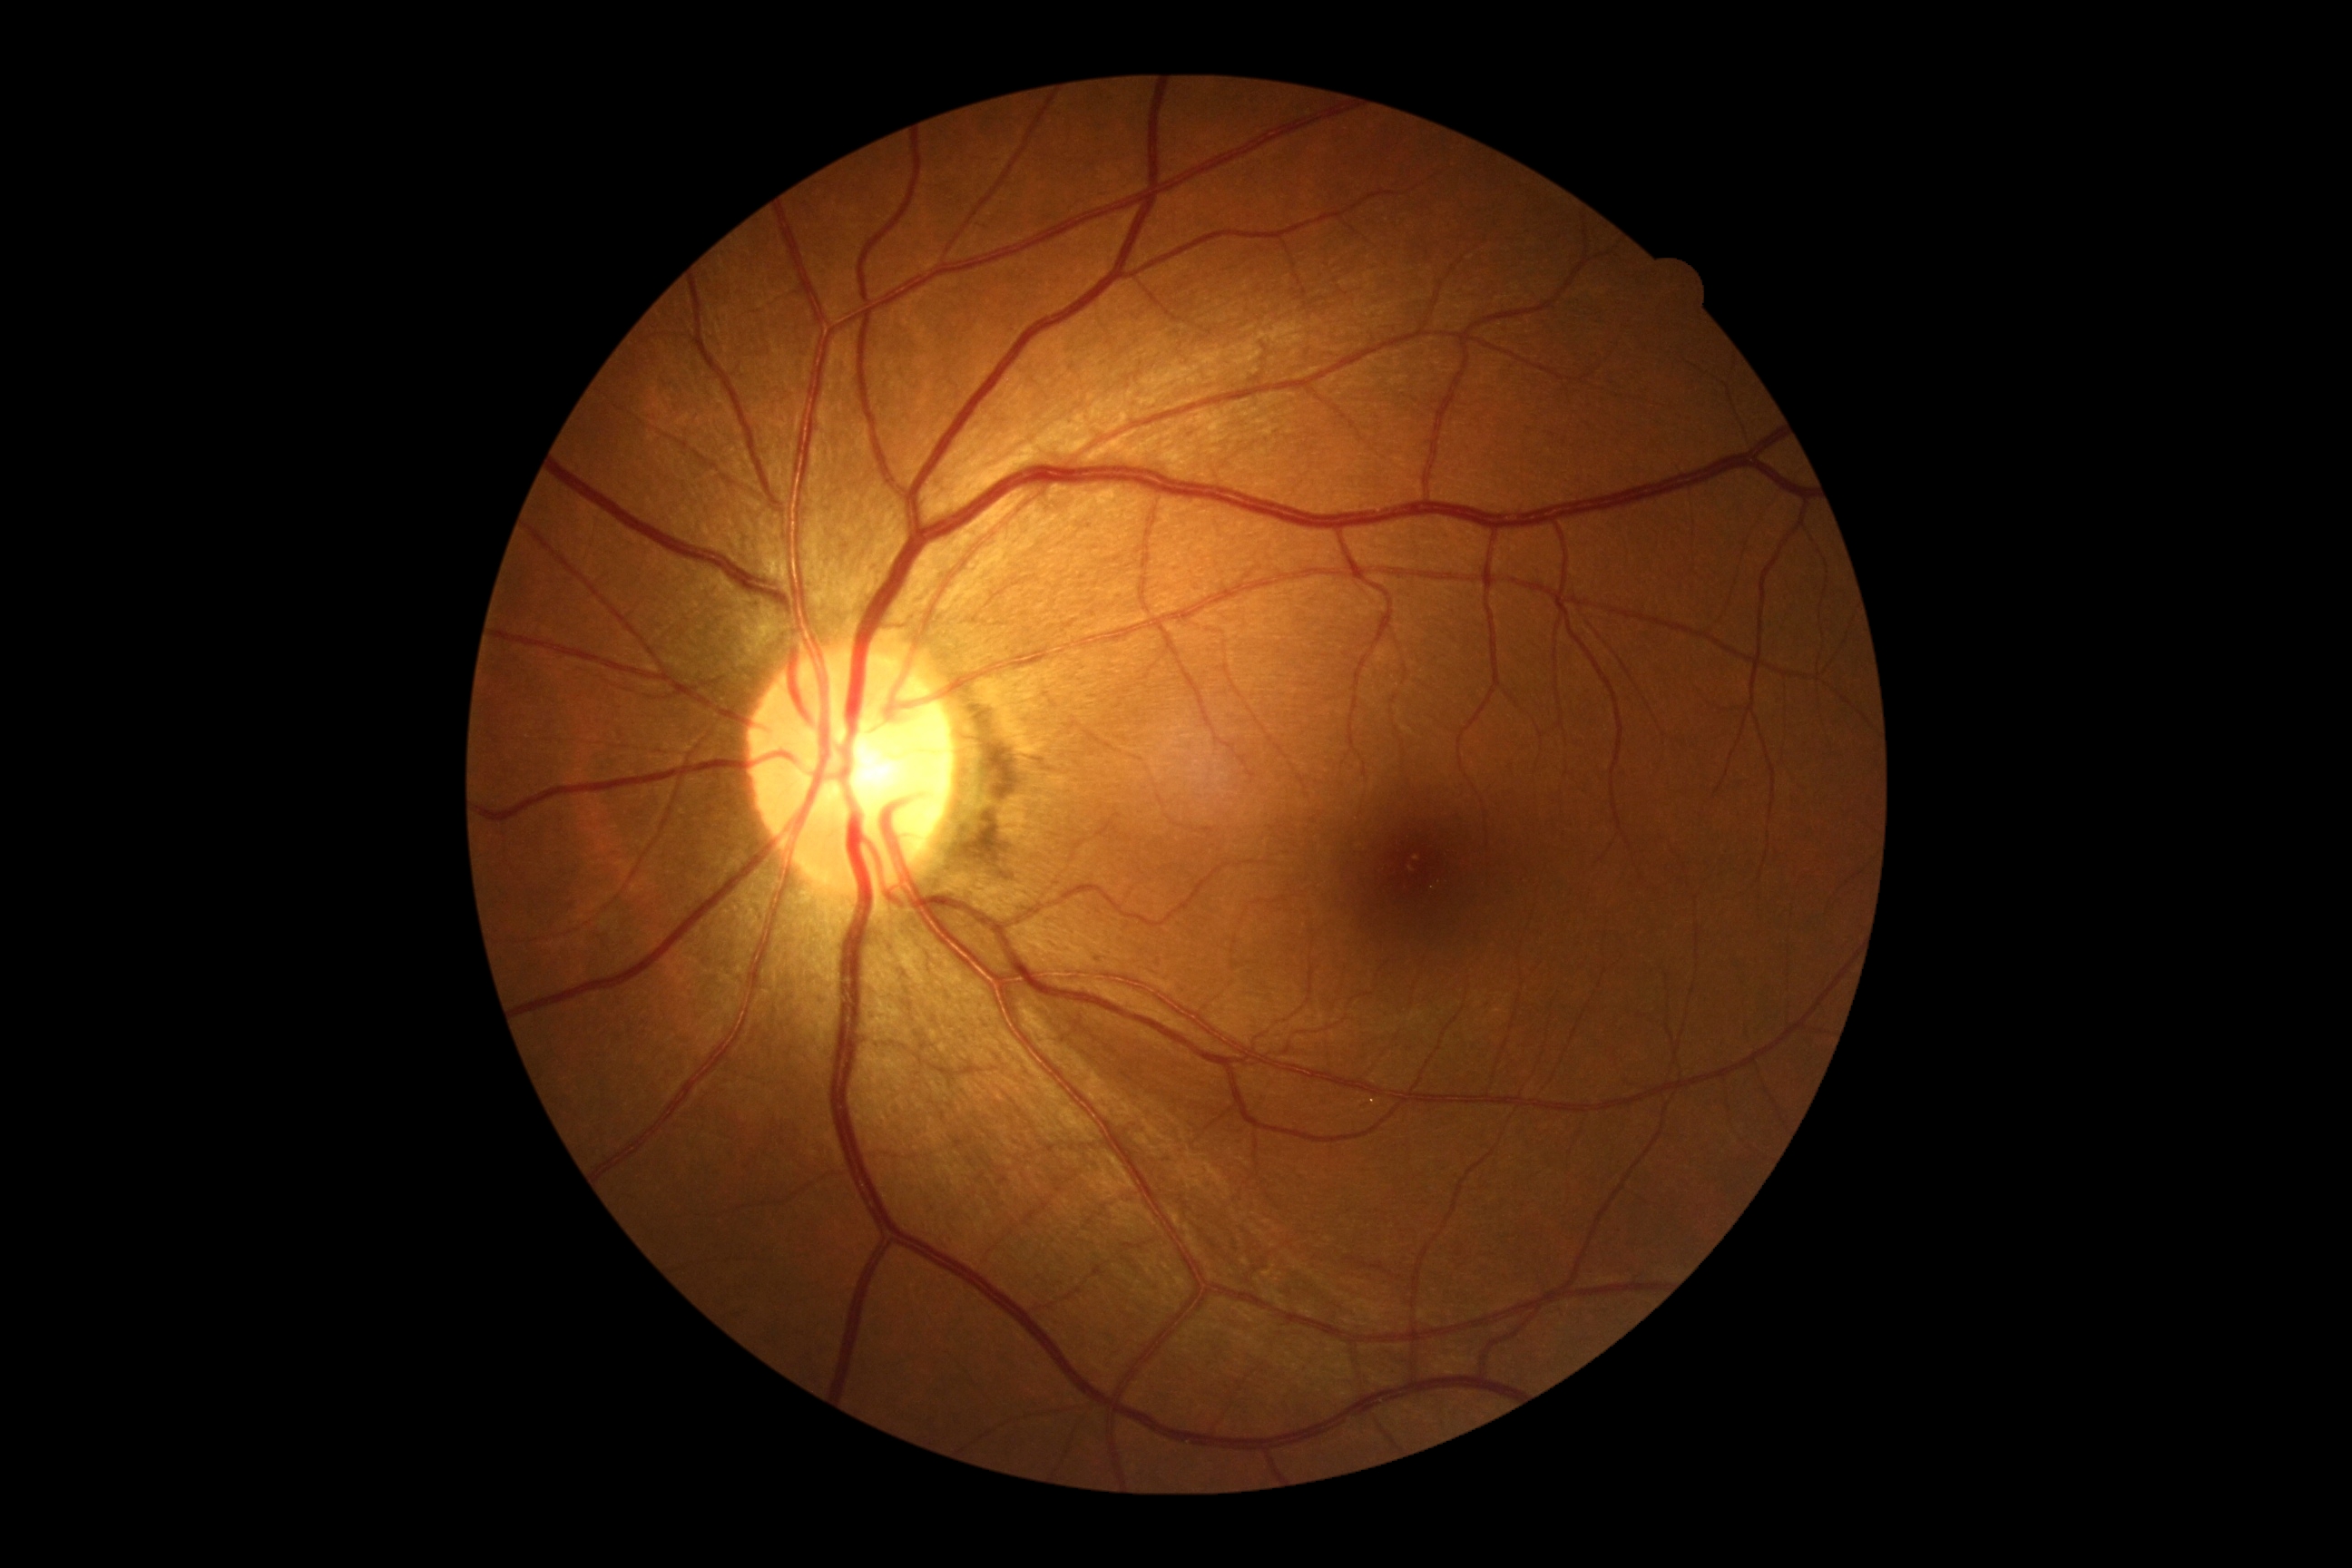

DR impression = negative for DR
DR severity = 0 — no visible signs of diabetic retinopathy